Fundus image cropped to the optic disc:
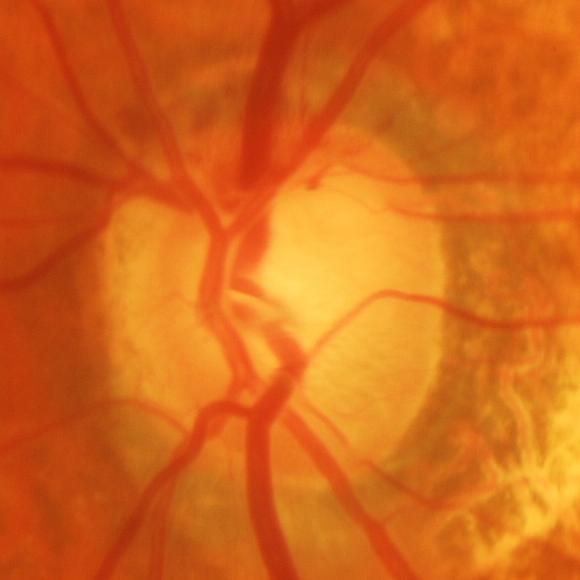

Assessment: glaucomatous changes.